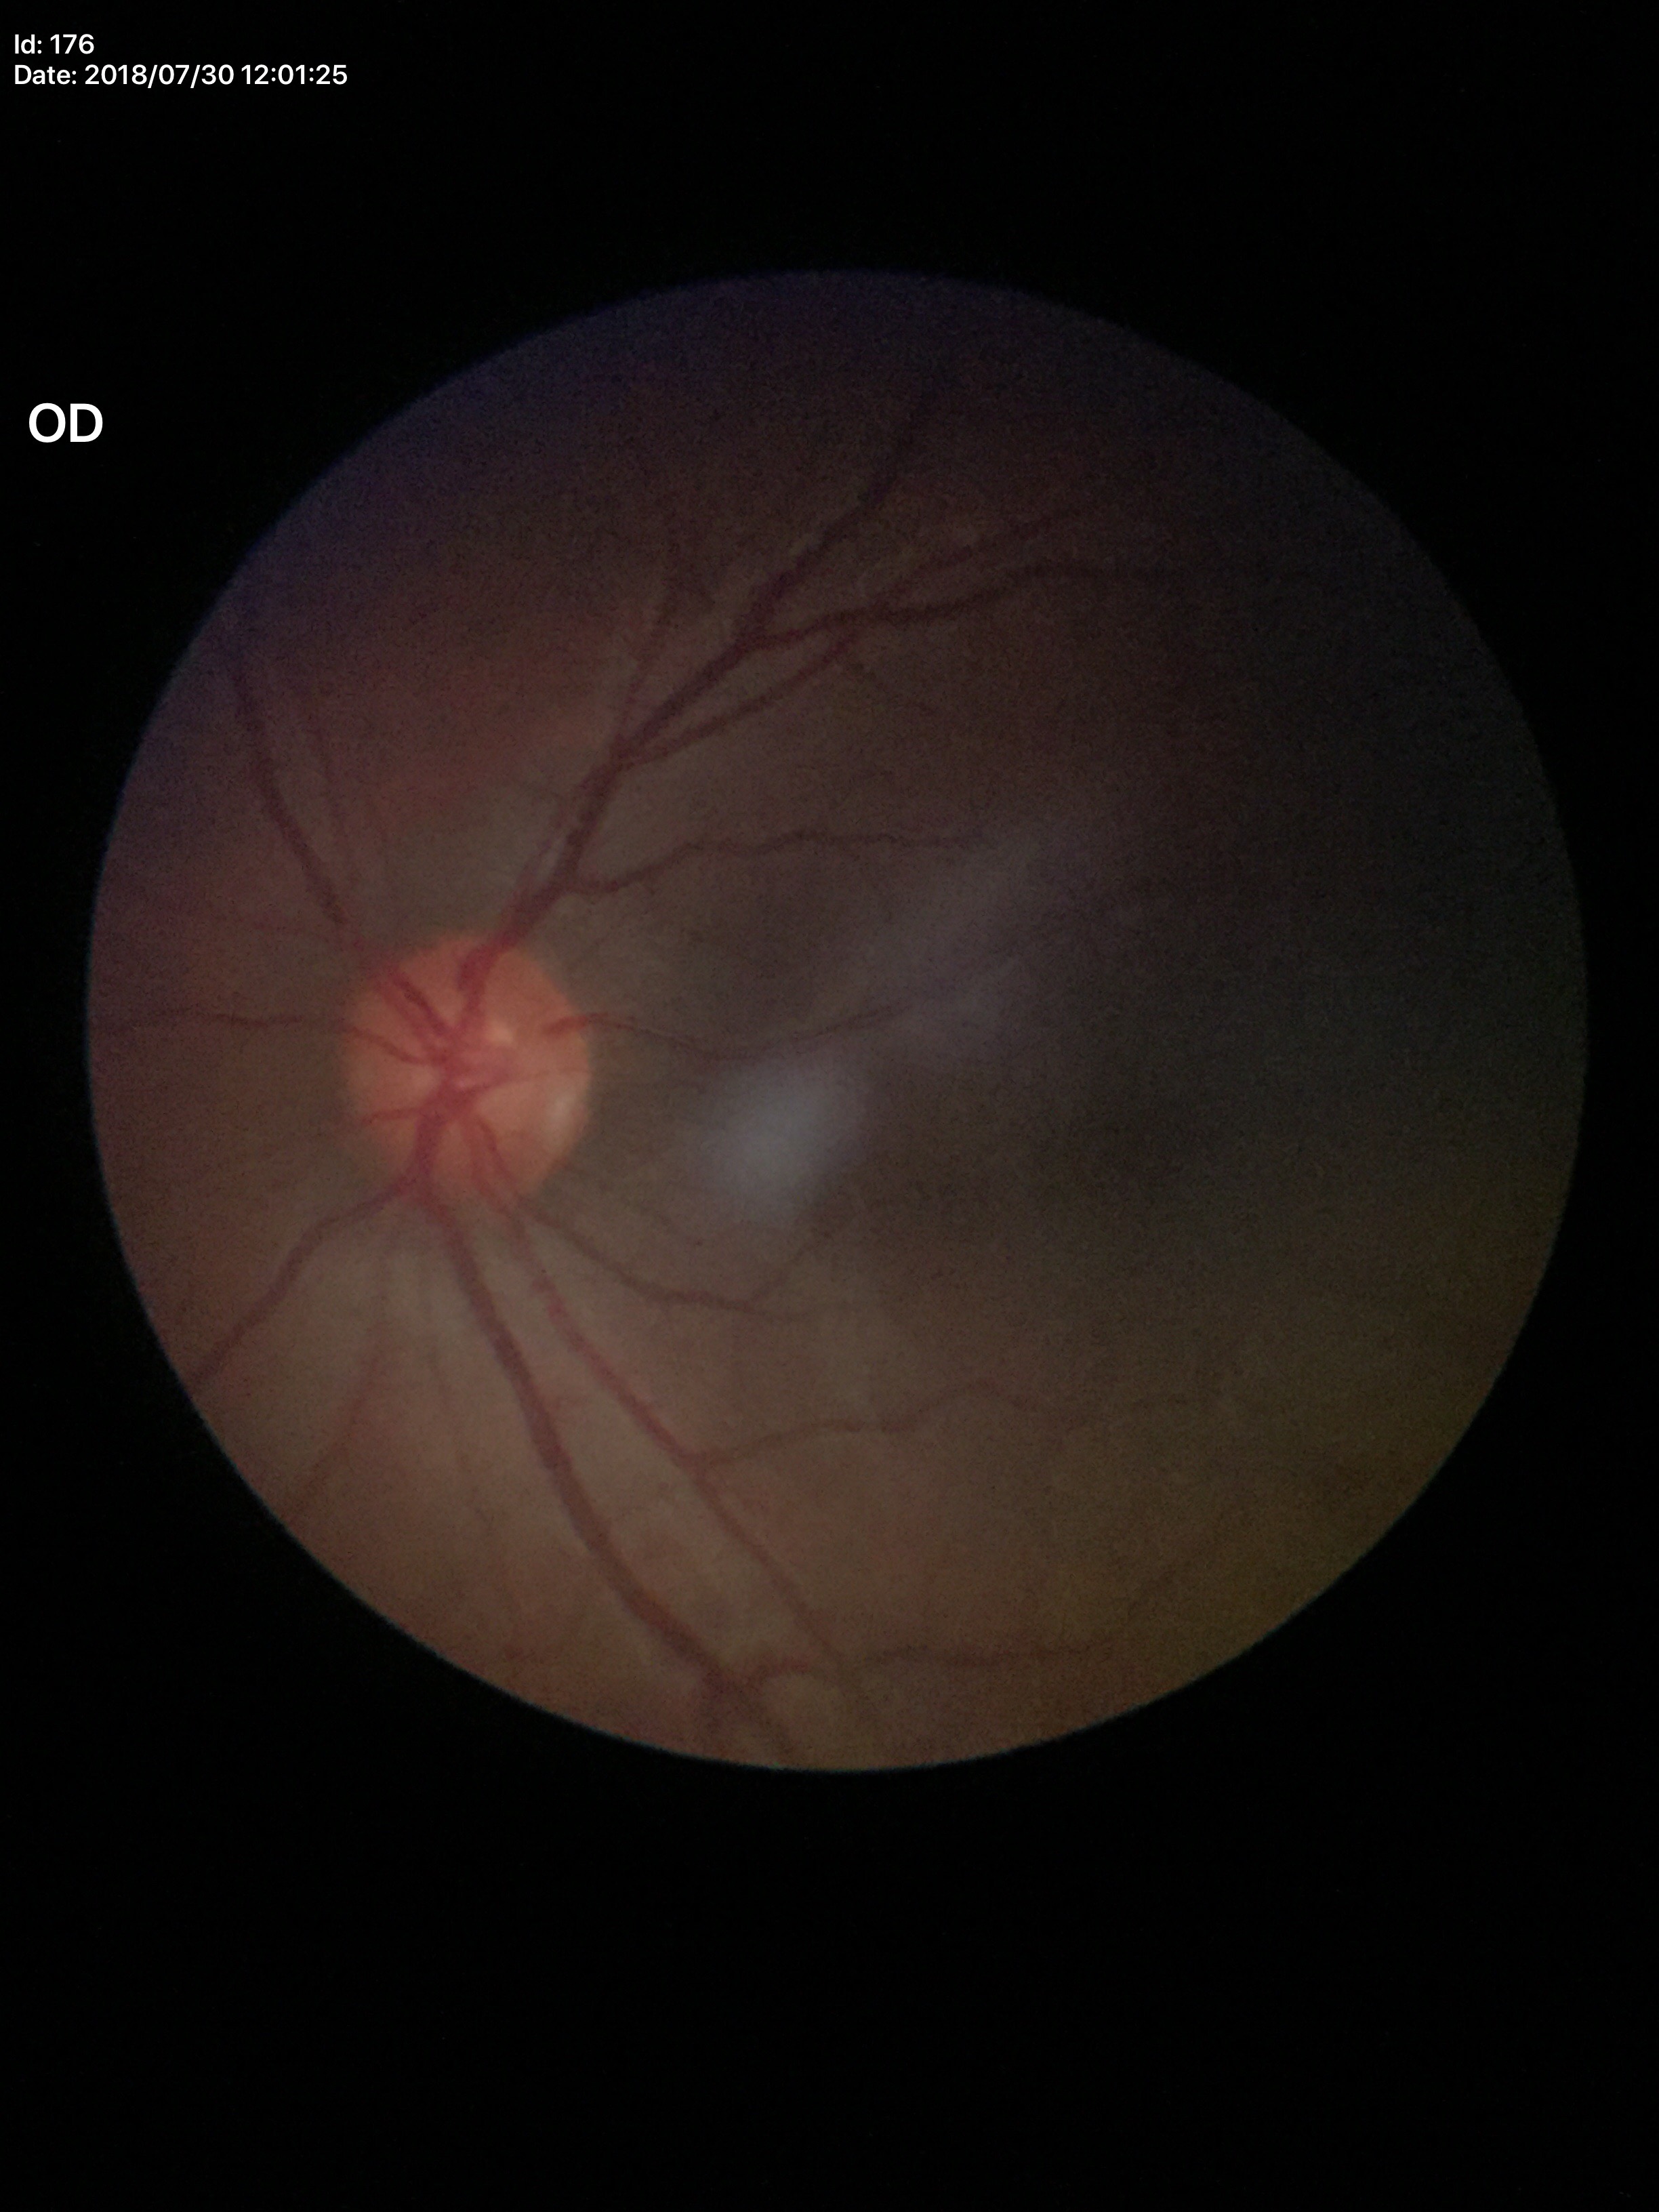

Glaucoma evaluation=negative
horizontal cup-to-disc ratio=0.48
vertical CDR=0.51